Posterior pole photograph, without pupil dilation: 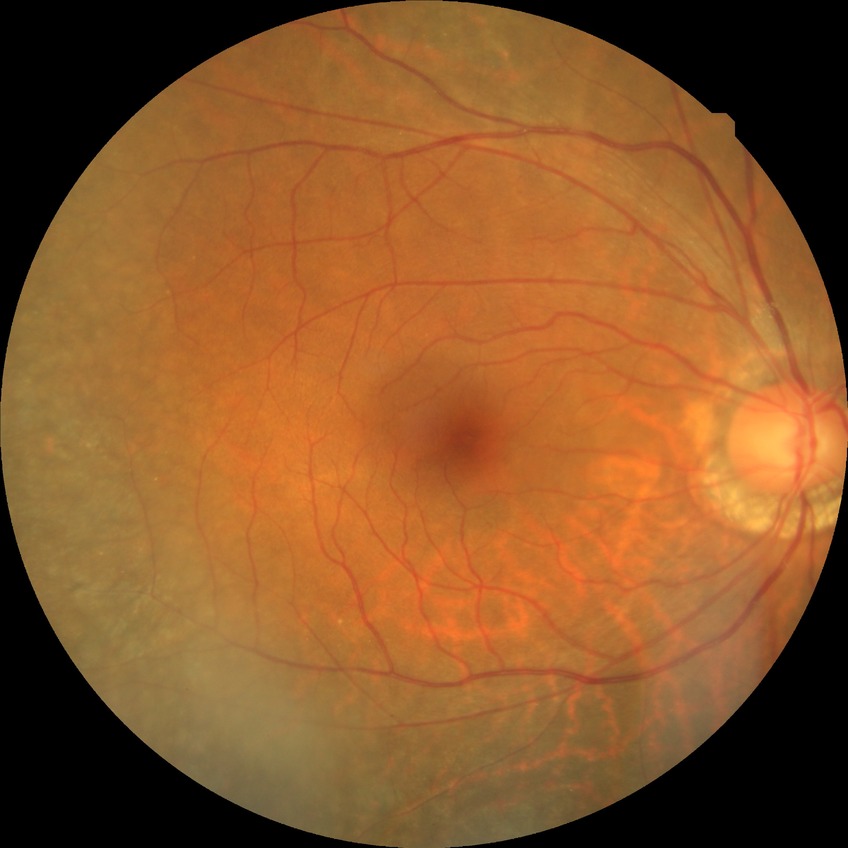

- DR severity: NDR